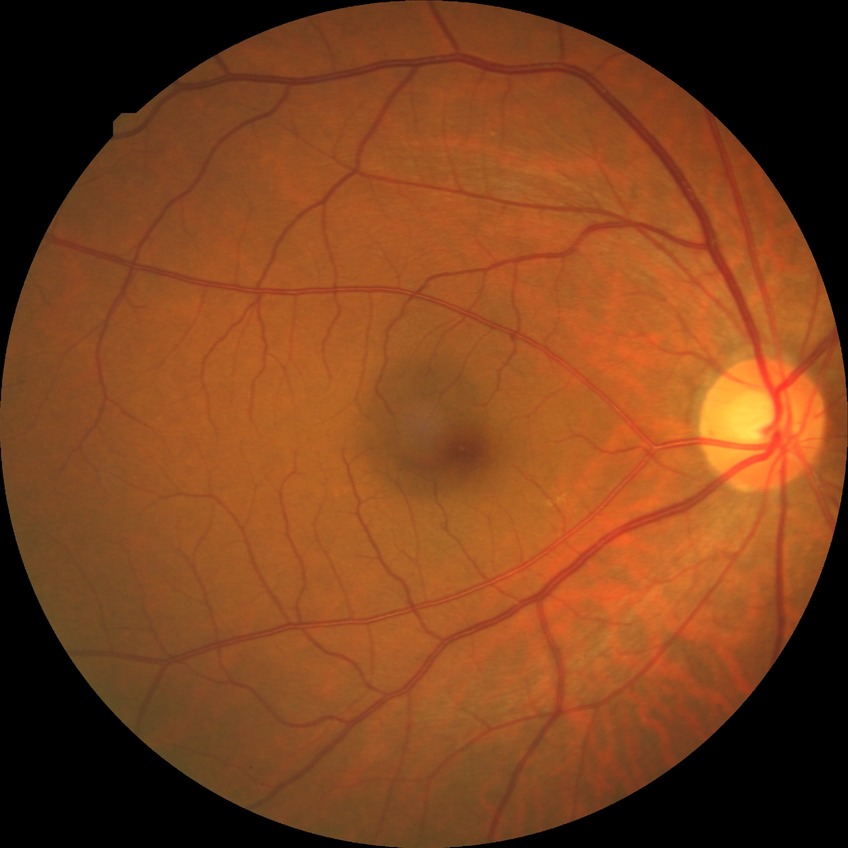

modified Davis grading: no diabetic retinopathy.